NIDEK AFC-230. 848x848: 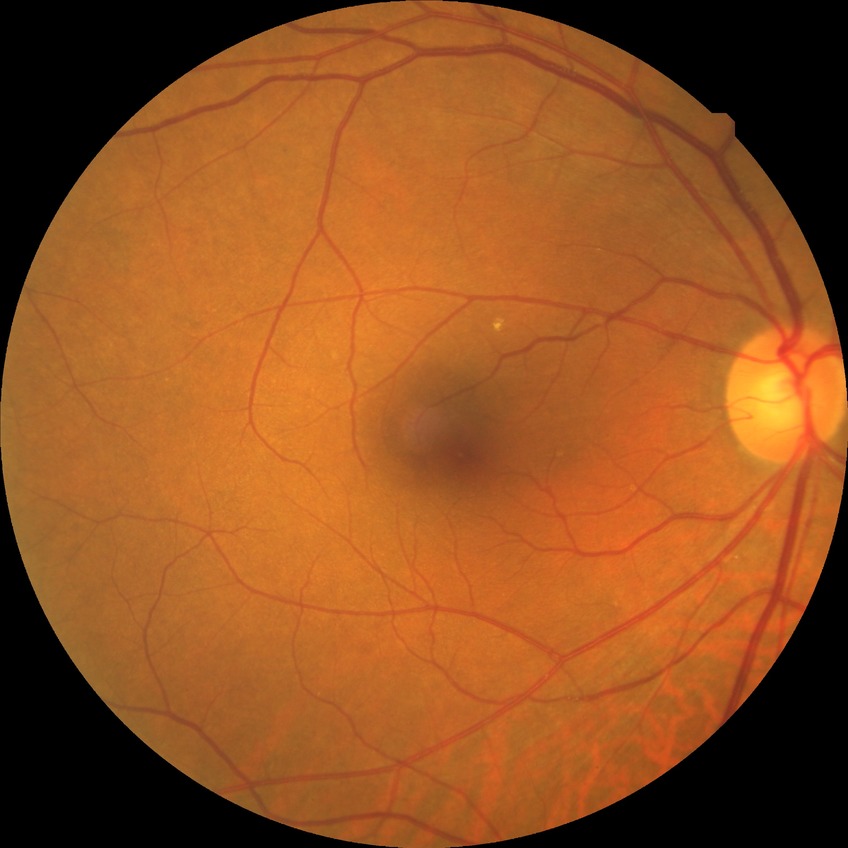
Modified Davis classification is no diabetic retinopathy.